Diabetic retinopathy graded by the modified Davis classification — 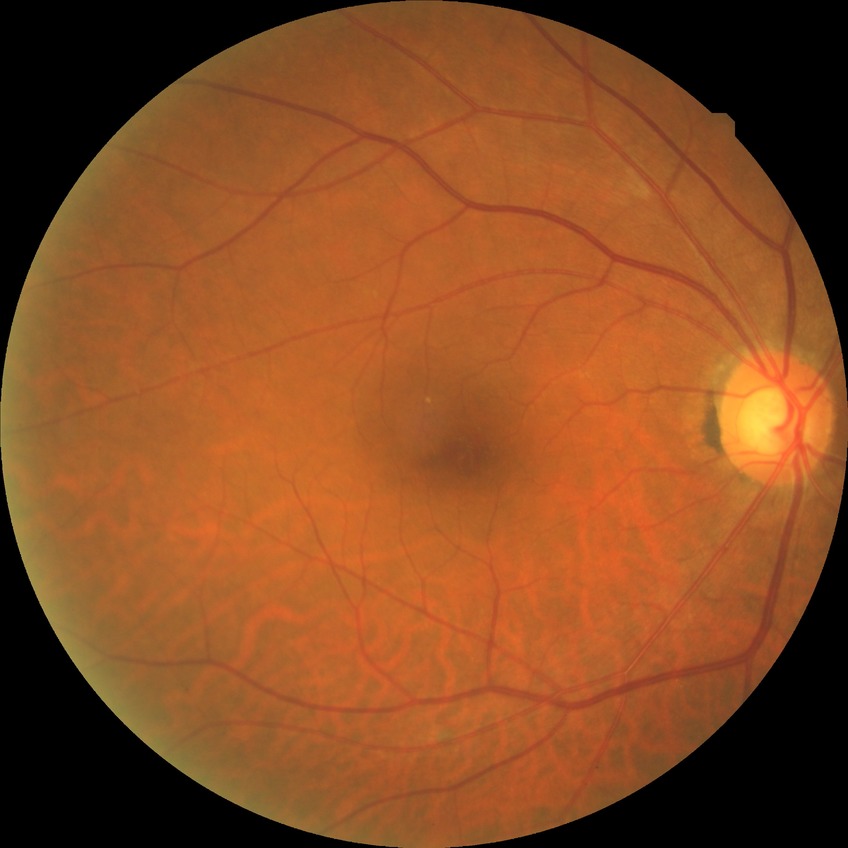

Diabetic retinopathy (DR) is NDR (no diabetic retinopathy).